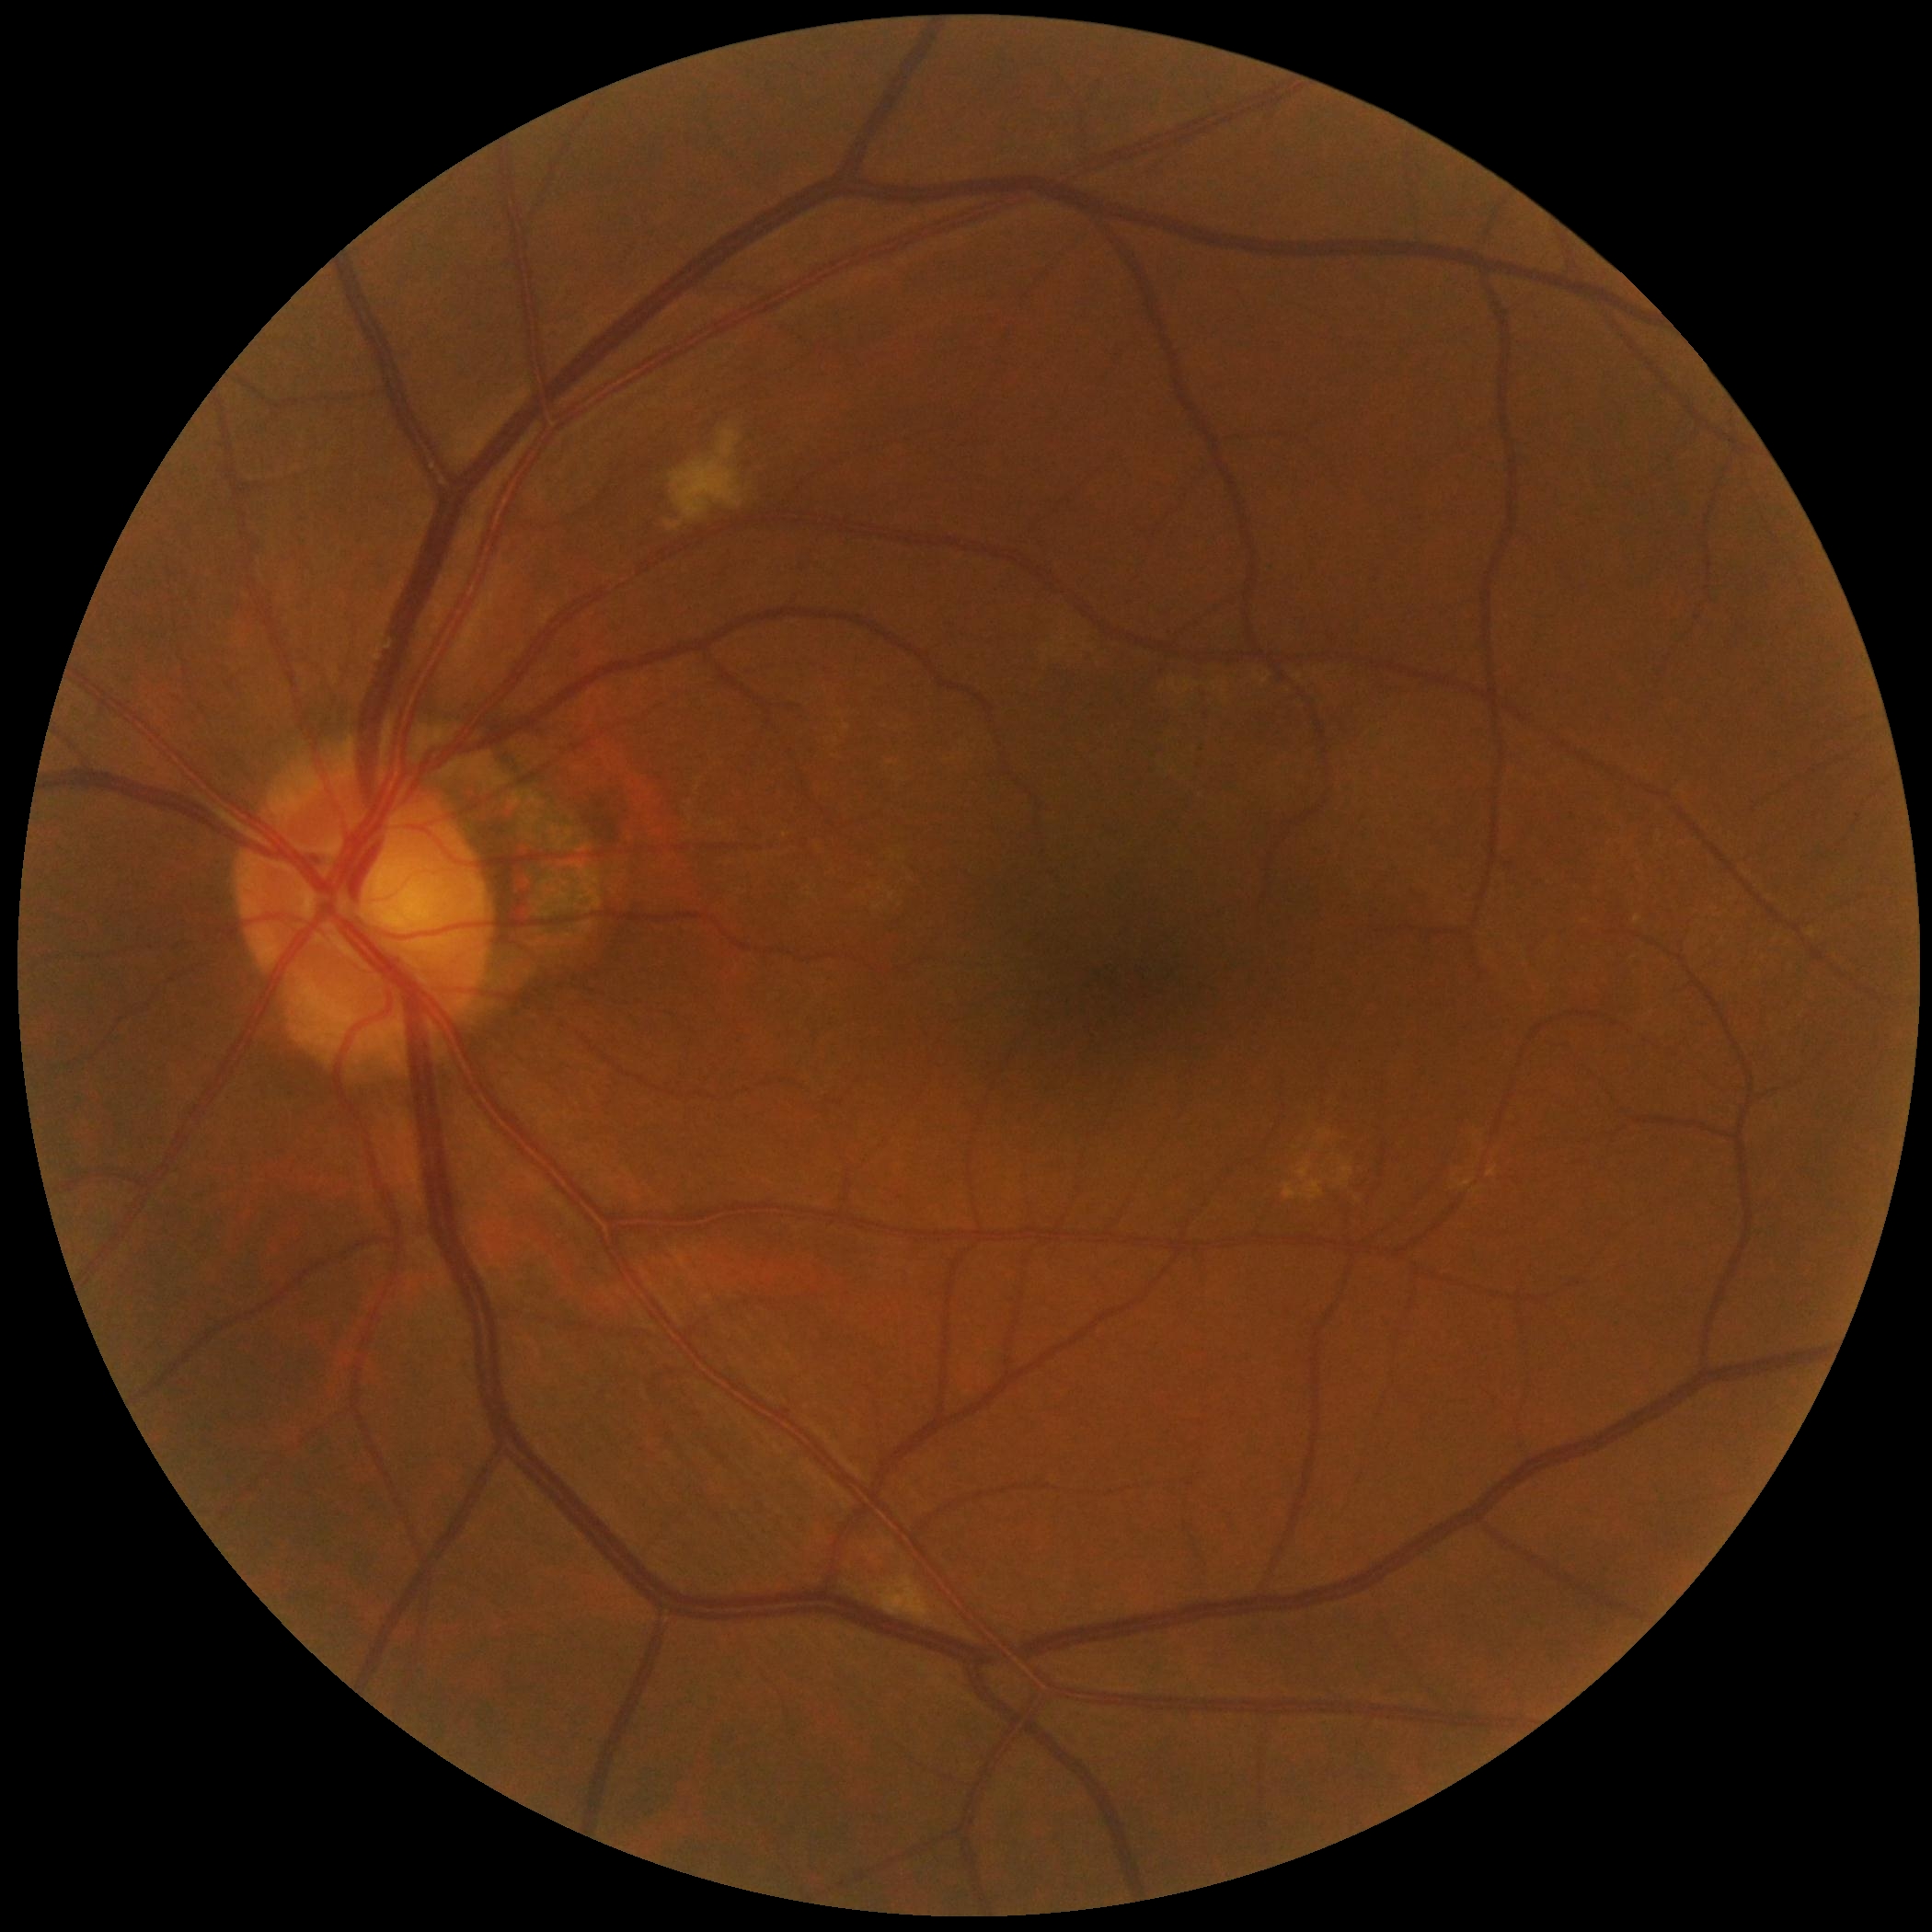
Retinopathy grade is 2 (moderate NPDR).